45-degree field of view; 2212 x 1659 pixels:
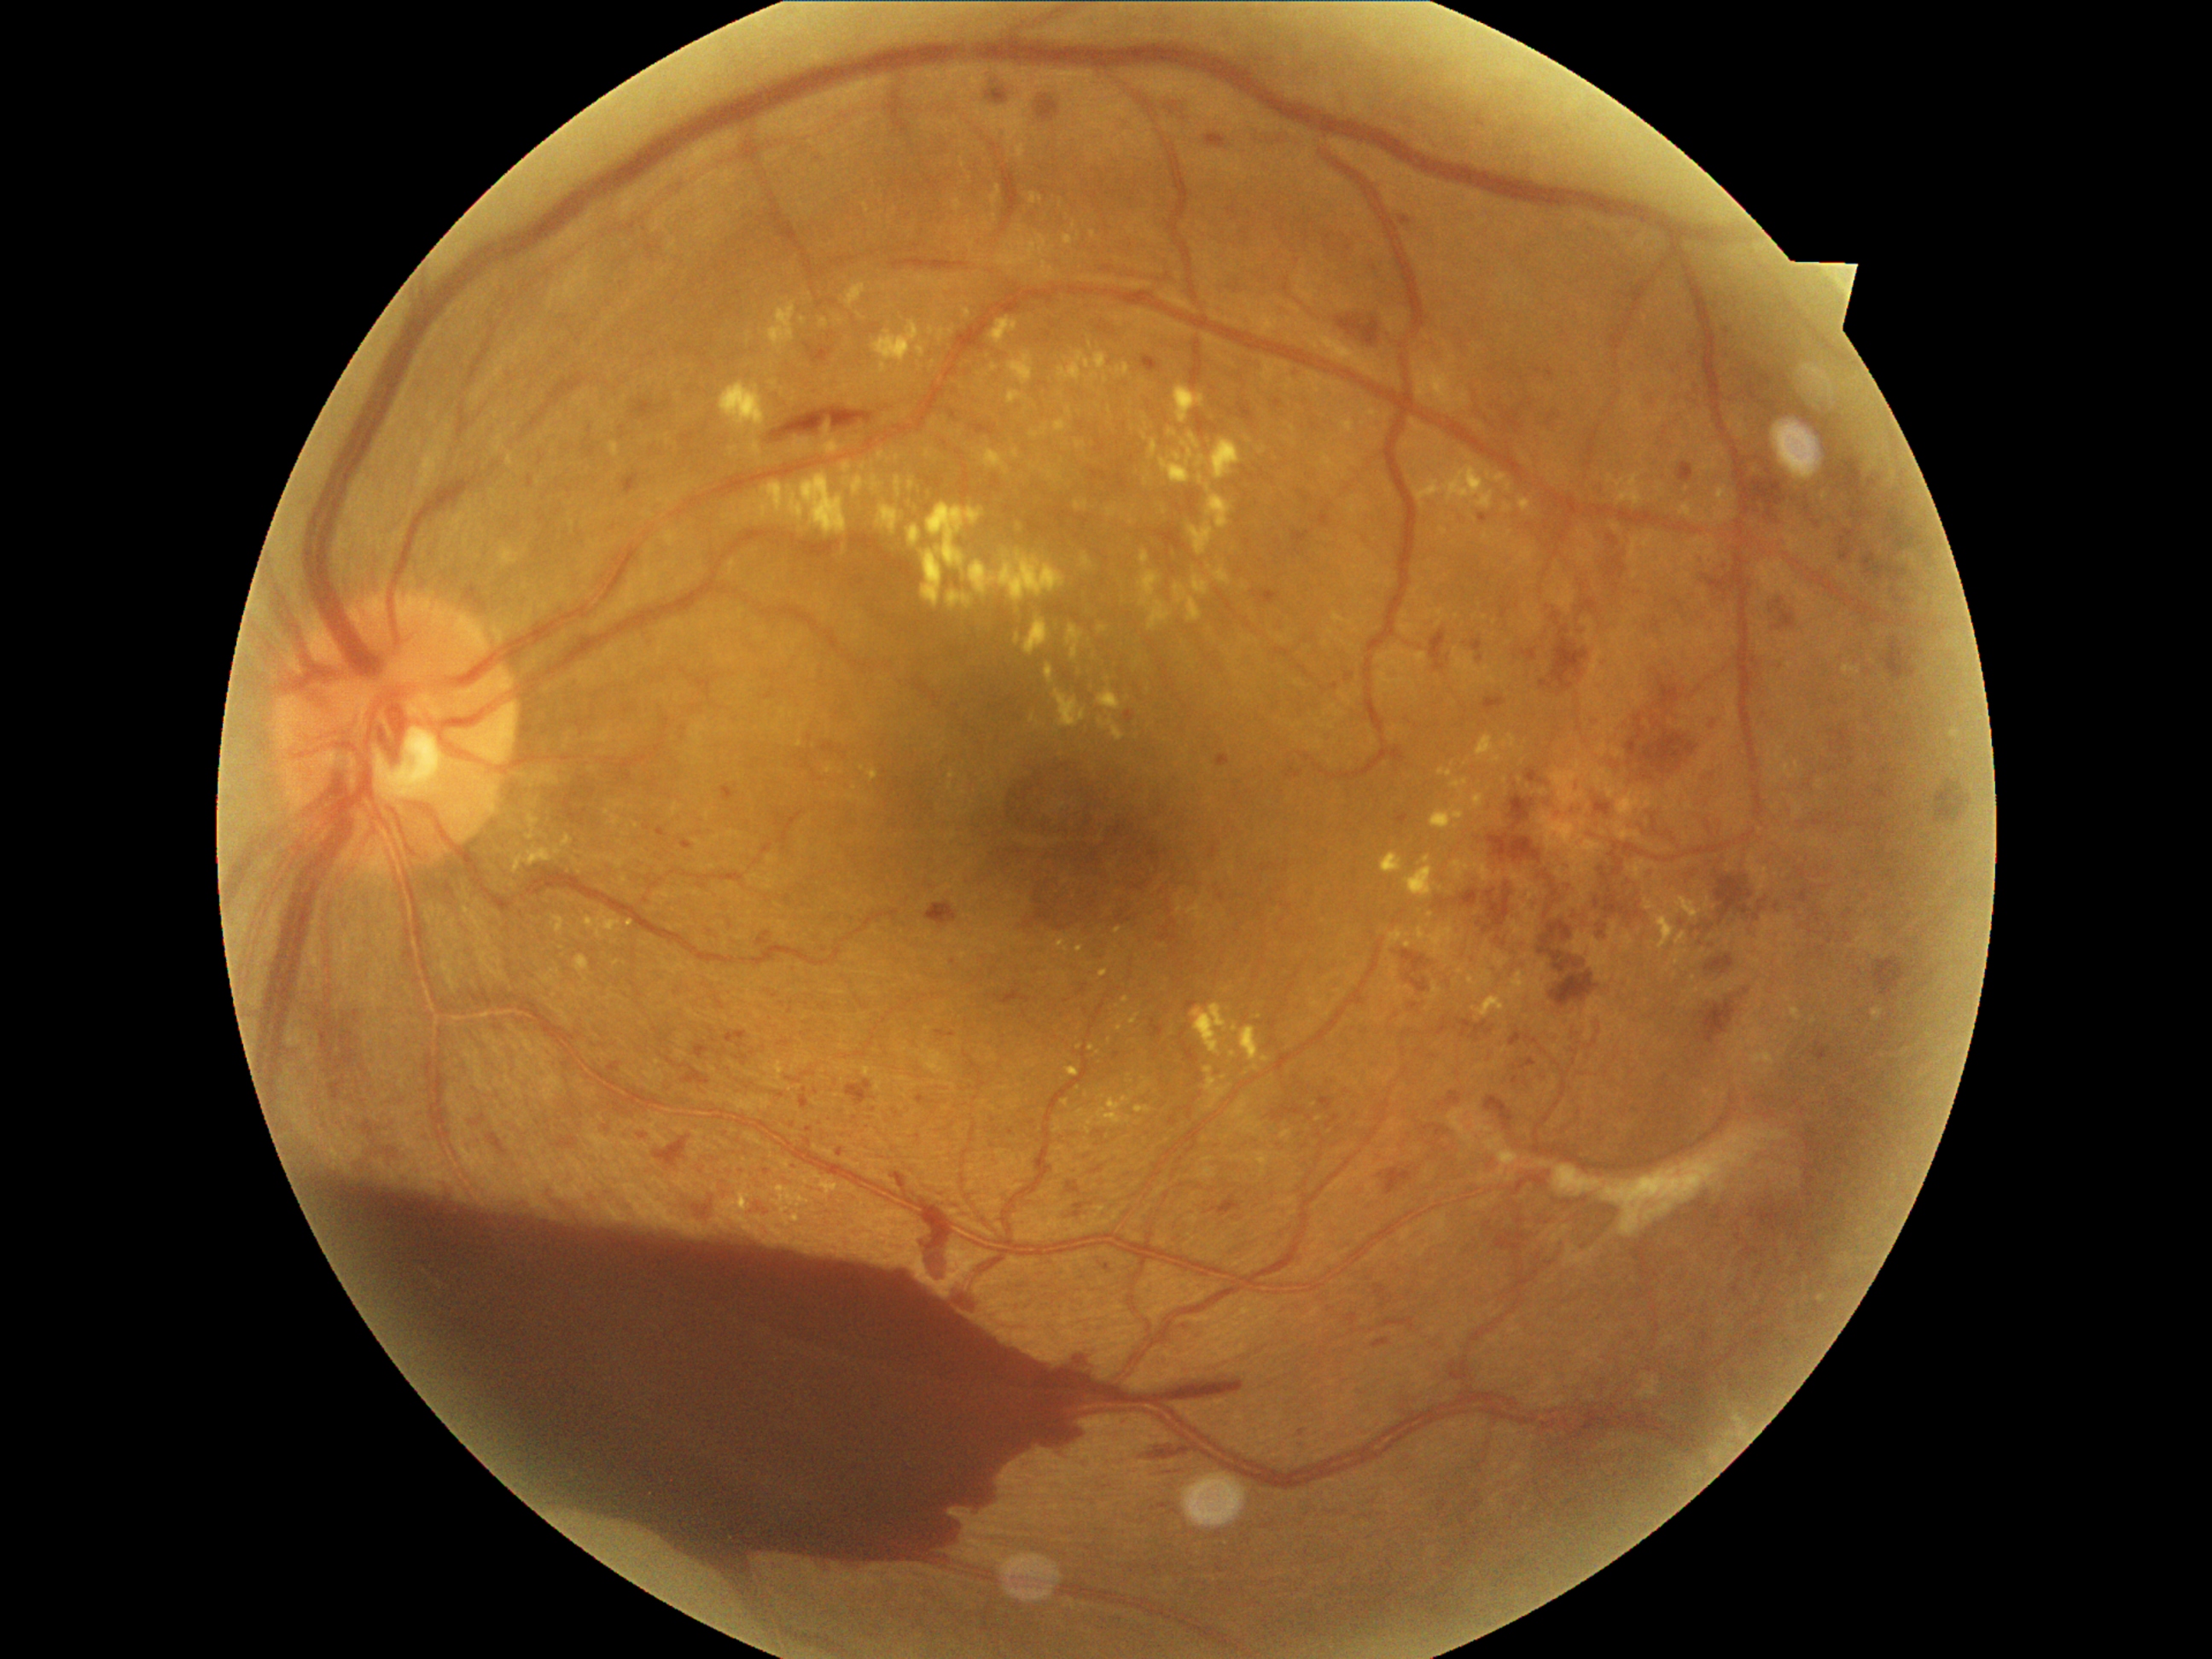
DR severity: grade 4 — neovascularization and/or vitreous/pre-retinal hemorrhage
Selected lesions:
MAs (partial) = 364, 1124, 373, 1132 | 1508, 1032, 1523, 1049 | 622, 472, 639, 496 | 1208, 1197, 1242, 1216 | 1068, 1182, 1080, 1196 | 1472, 641, 1482, 651 | 1875, 788, 1894, 800 | 1679, 463, 1694, 484 | 639, 1134, 648, 1139 | 1909, 535, 1919, 542 | 1165, 96, 1184, 124 | 1346, 1313, 1358, 1325 | 1126, 711, 1136, 723 | 1895, 597, 1907, 605
Small MAs approximately at <pt>482,1118</pt> | <pt>1808,509</pt> | <pt>1561,416</pt> | <pt>1539,370</pt> | <pt>1714,727</pt> | <pt>809,1129</pt>
EXs (partial) = 878, 506, 900, 535 | 1076, 441, 1085, 450 | 1032, 194, 1044, 204 | 1452, 859, 1470, 880 | 1187, 433, 1202, 450 | 842, 475, 883, 498 | 1136, 1107, 1151, 1114 | 1117, 363, 1131, 376 | 1416, 928, 1460, 958 | 1474, 970, 1527, 1018 | 1150, 439, 1158, 458 | 1090, 231, 1097, 240 | 1131, 1015, 1139, 1025
Small EXs approximately at <pt>853,404</pt> | <pt>1462,506</pt> | <pt>1091,1048</pt> | <pt>1259,1018</pt> | <pt>1427,1009</pt> | <pt>733,450</pt>